Image size 848x848 — 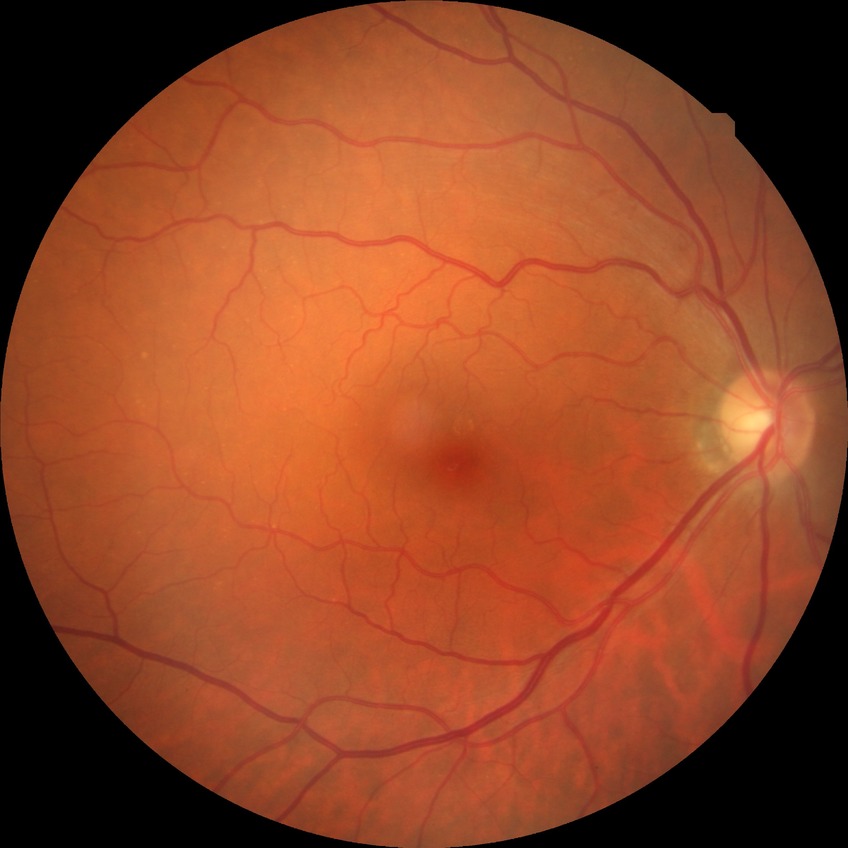

Findings:
* Davis stage — NDR
* DR impression — no signs of DR